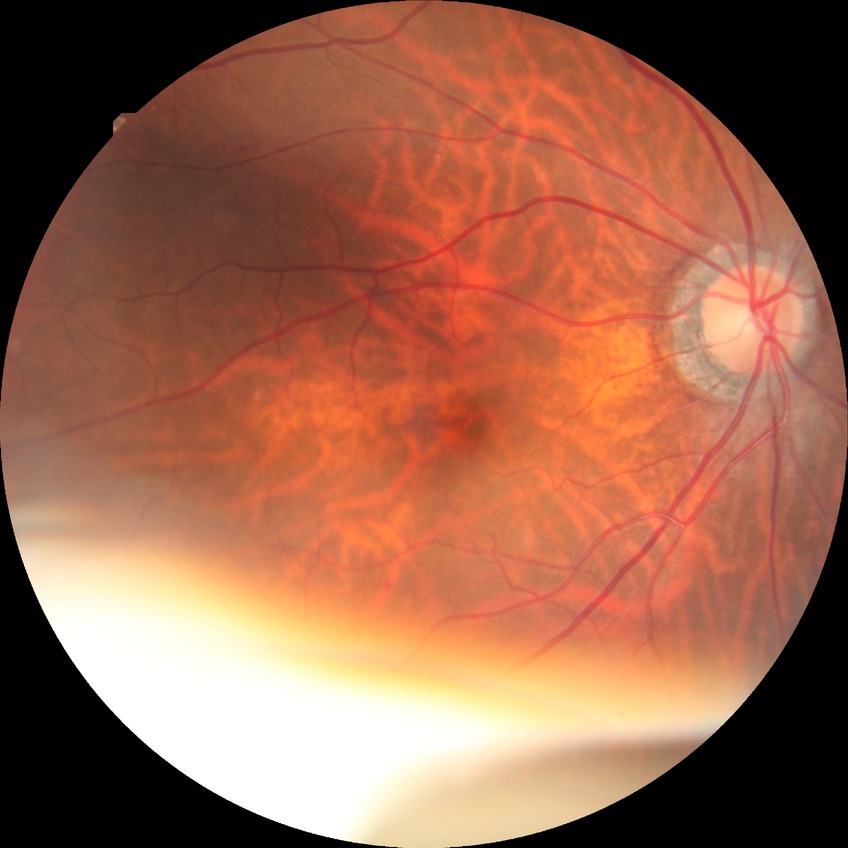

Davis grading is simple diabetic retinopathy.